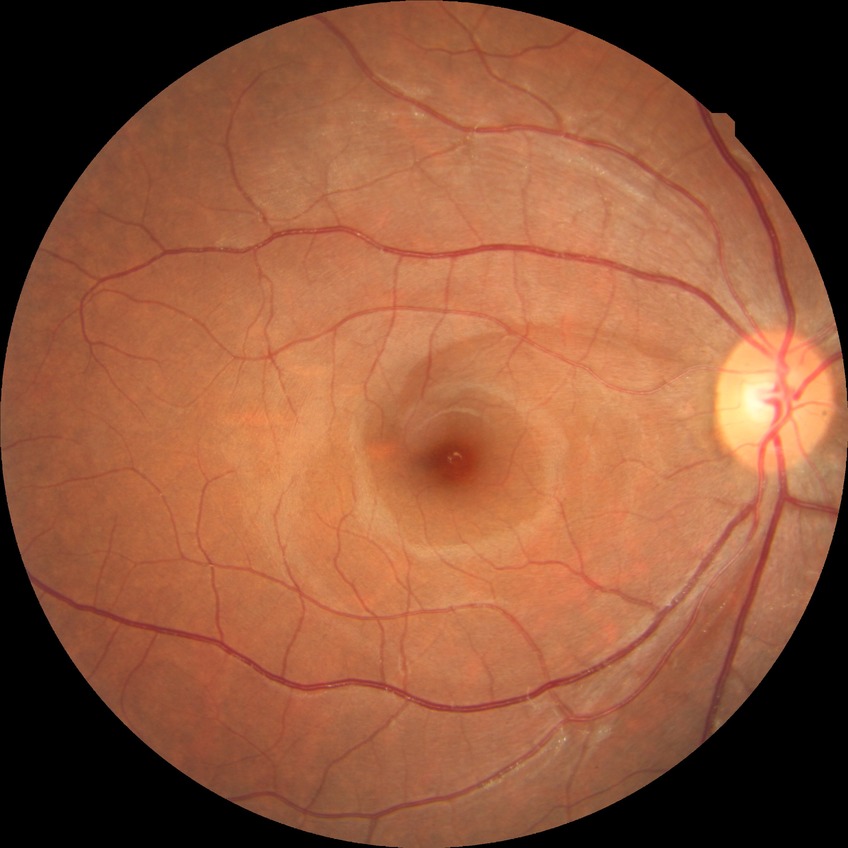 {"davis_grade": "NDR (no diabetic retinopathy)"}